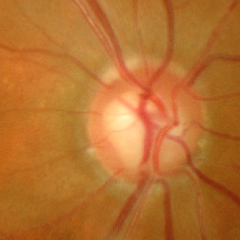 Findings consistent with severe glaucomatous damage.